DR severity per modified Davis staging — 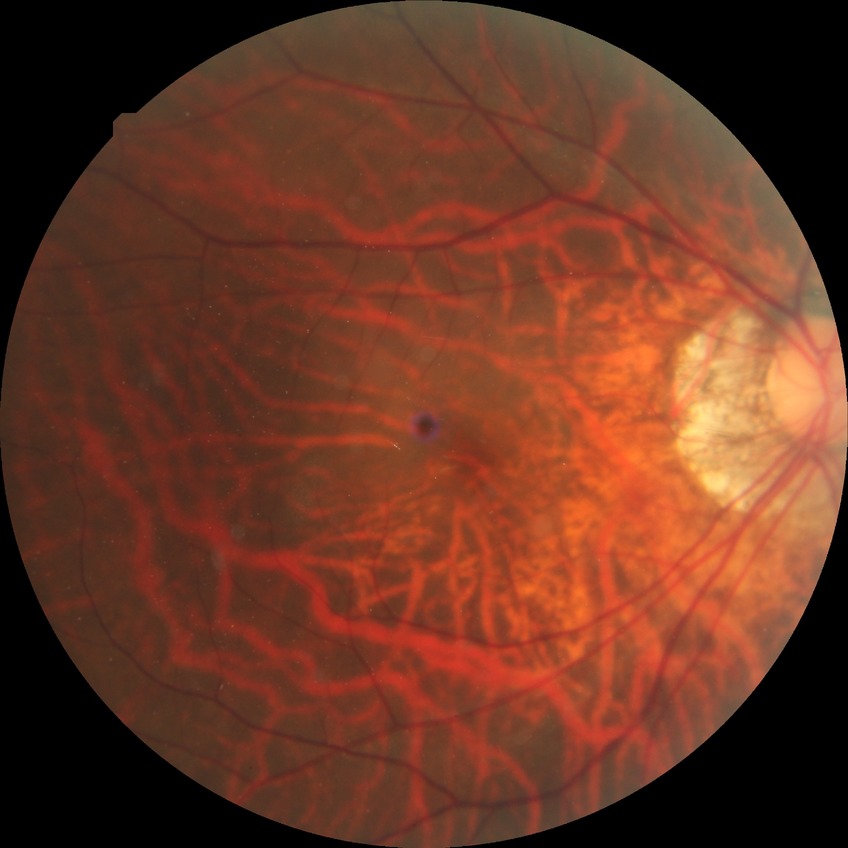 Diabetic retinopathy grade: no diabetic retinopathy.